Retinal fundus photograph: 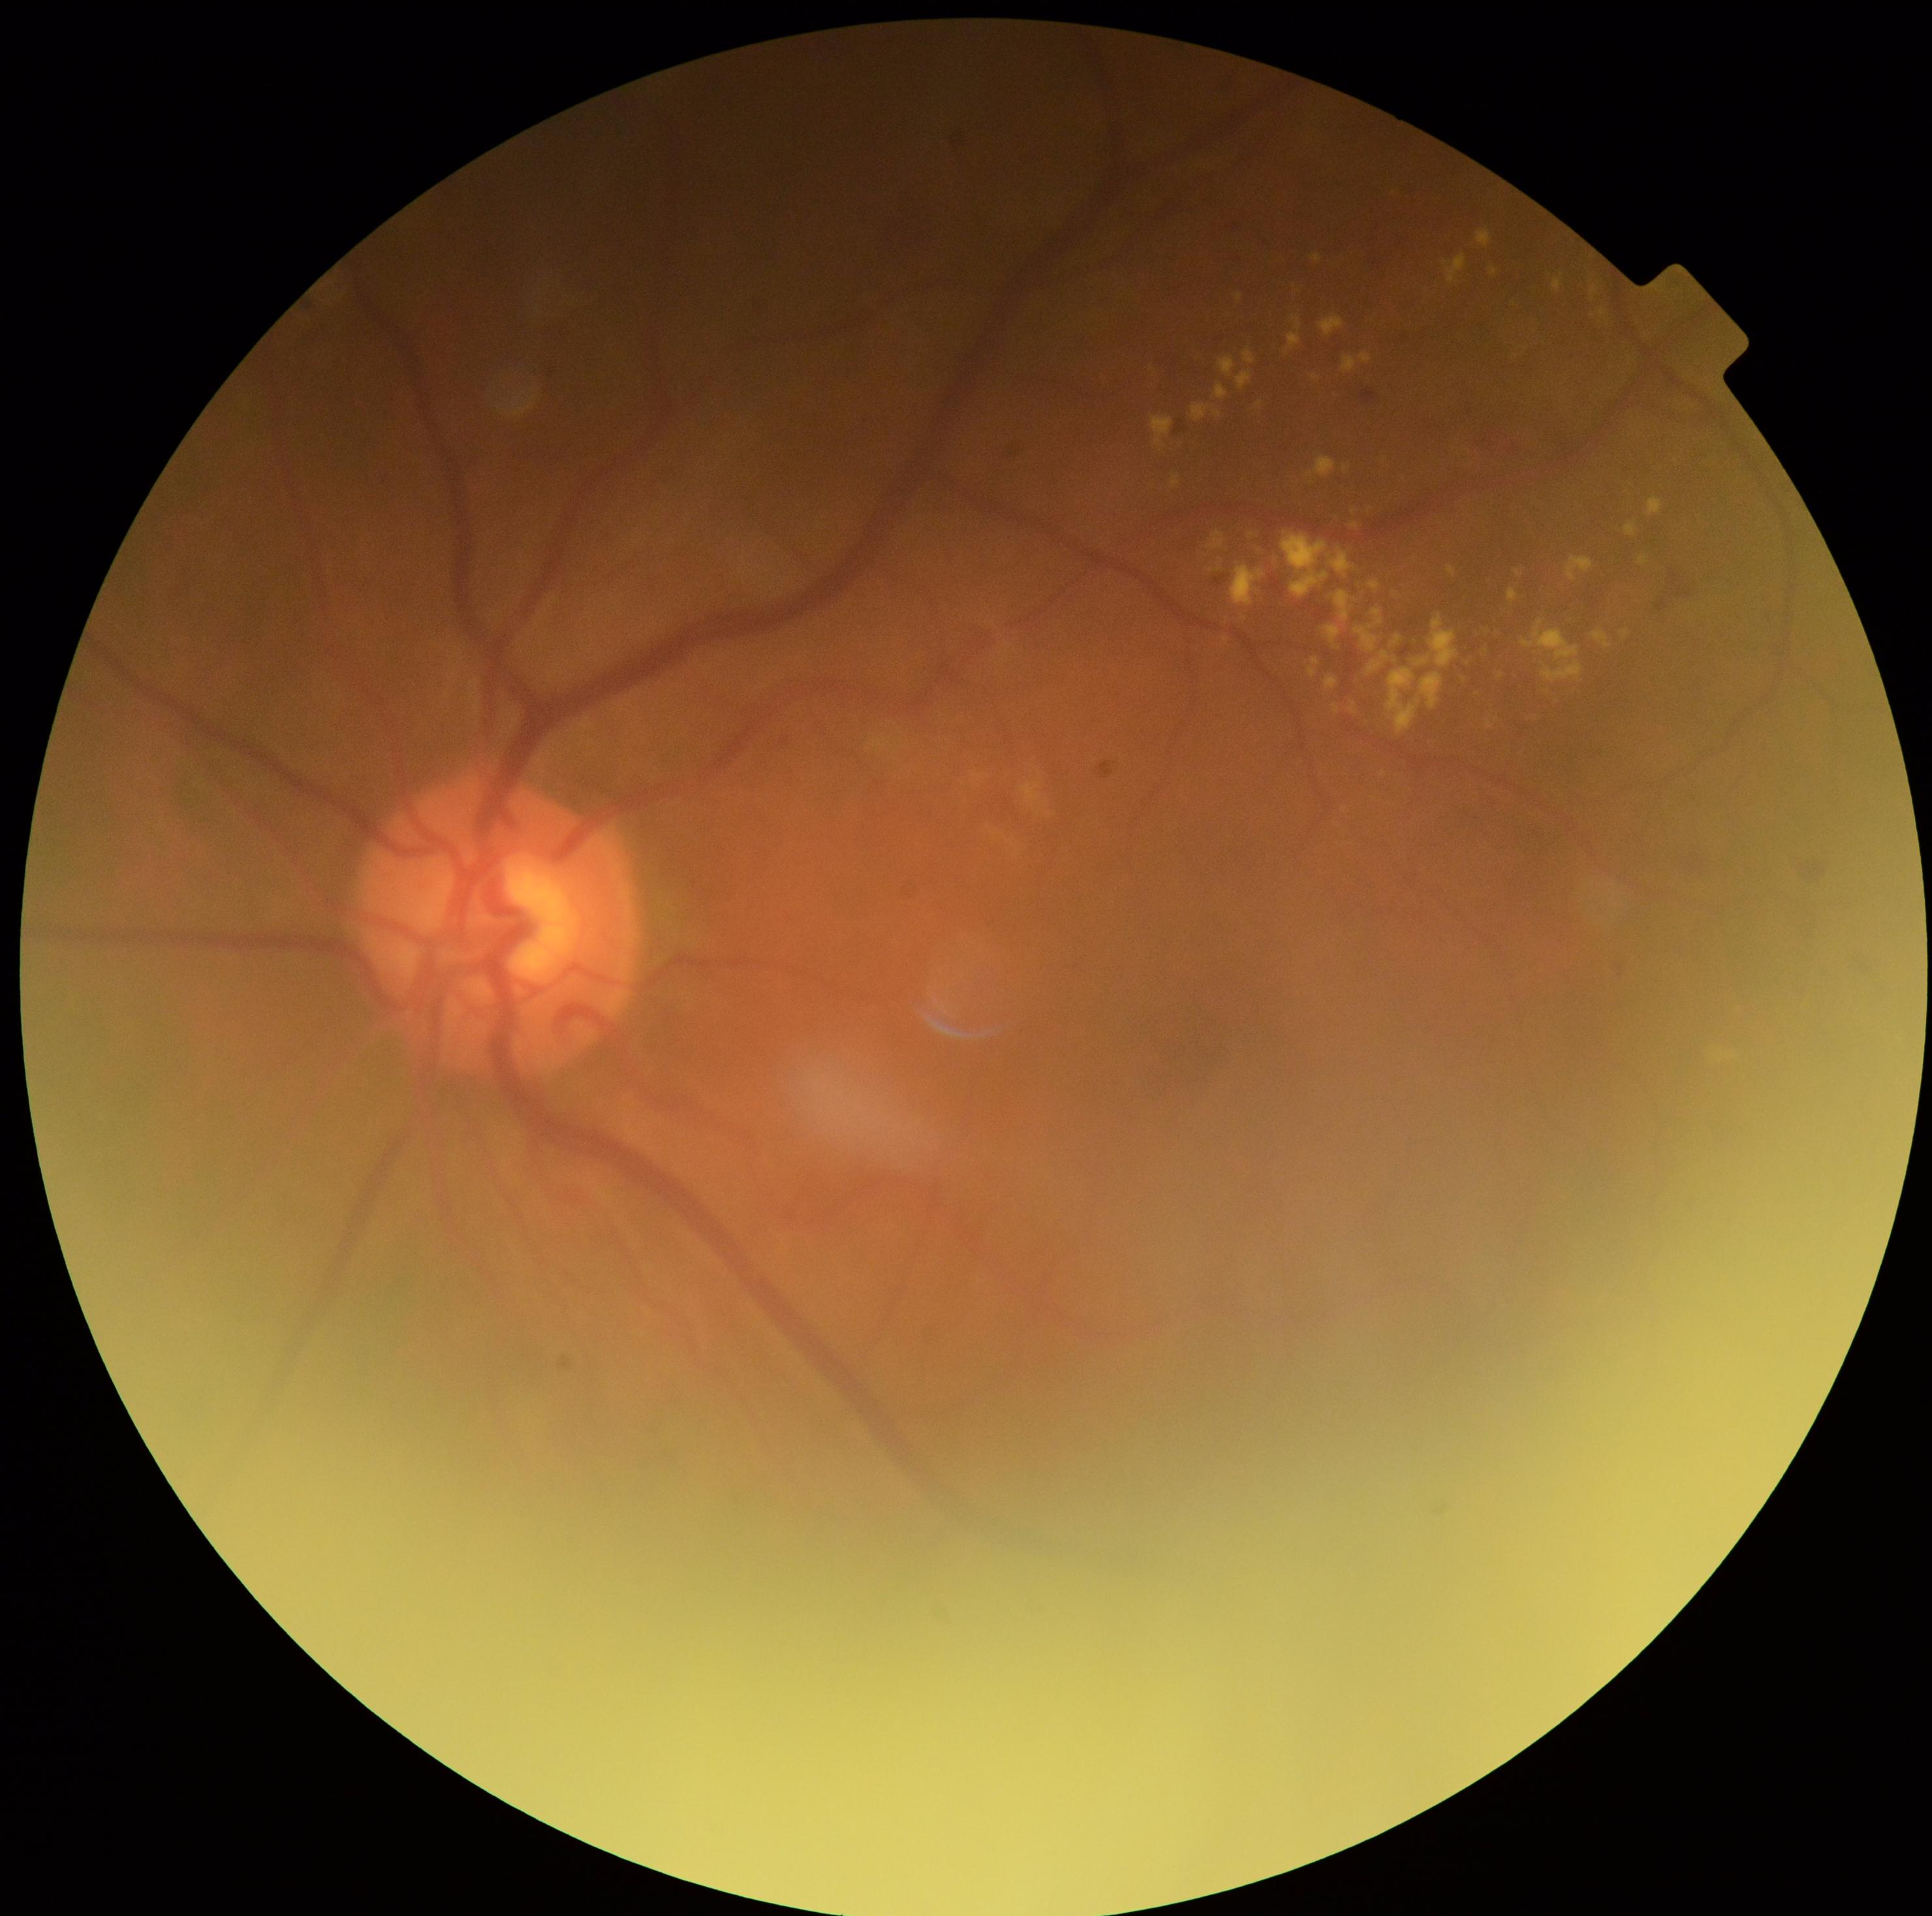 Disease class: non-proliferative diabetic retinopathy. Retinopathy: grade 2 (moderate NPDR) — more than just microaneurysms but less than severe NPDR.